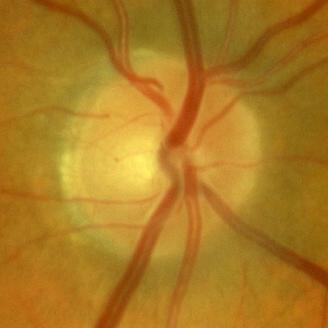

Glaucoma diagnosis: no glaucomatous findings.